Camera: NIDEK AFC-230, without pupil dilation, 848 by 848 pixels, posterior pole color fundus photograph:
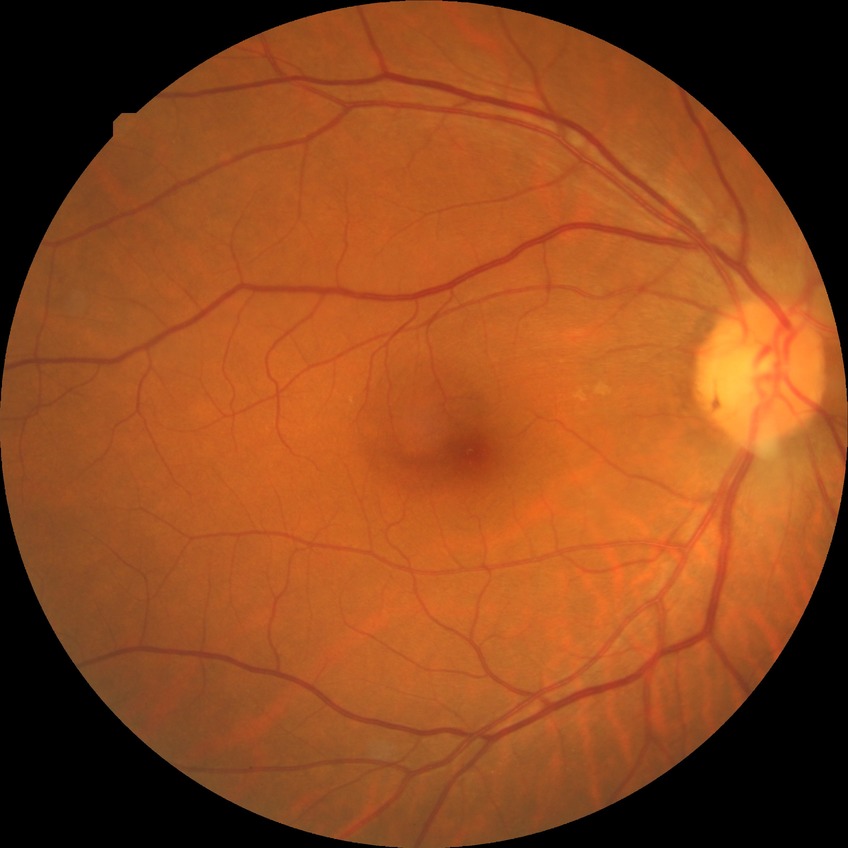

Diabetic retinopathy grade: no diabetic retinopathy.